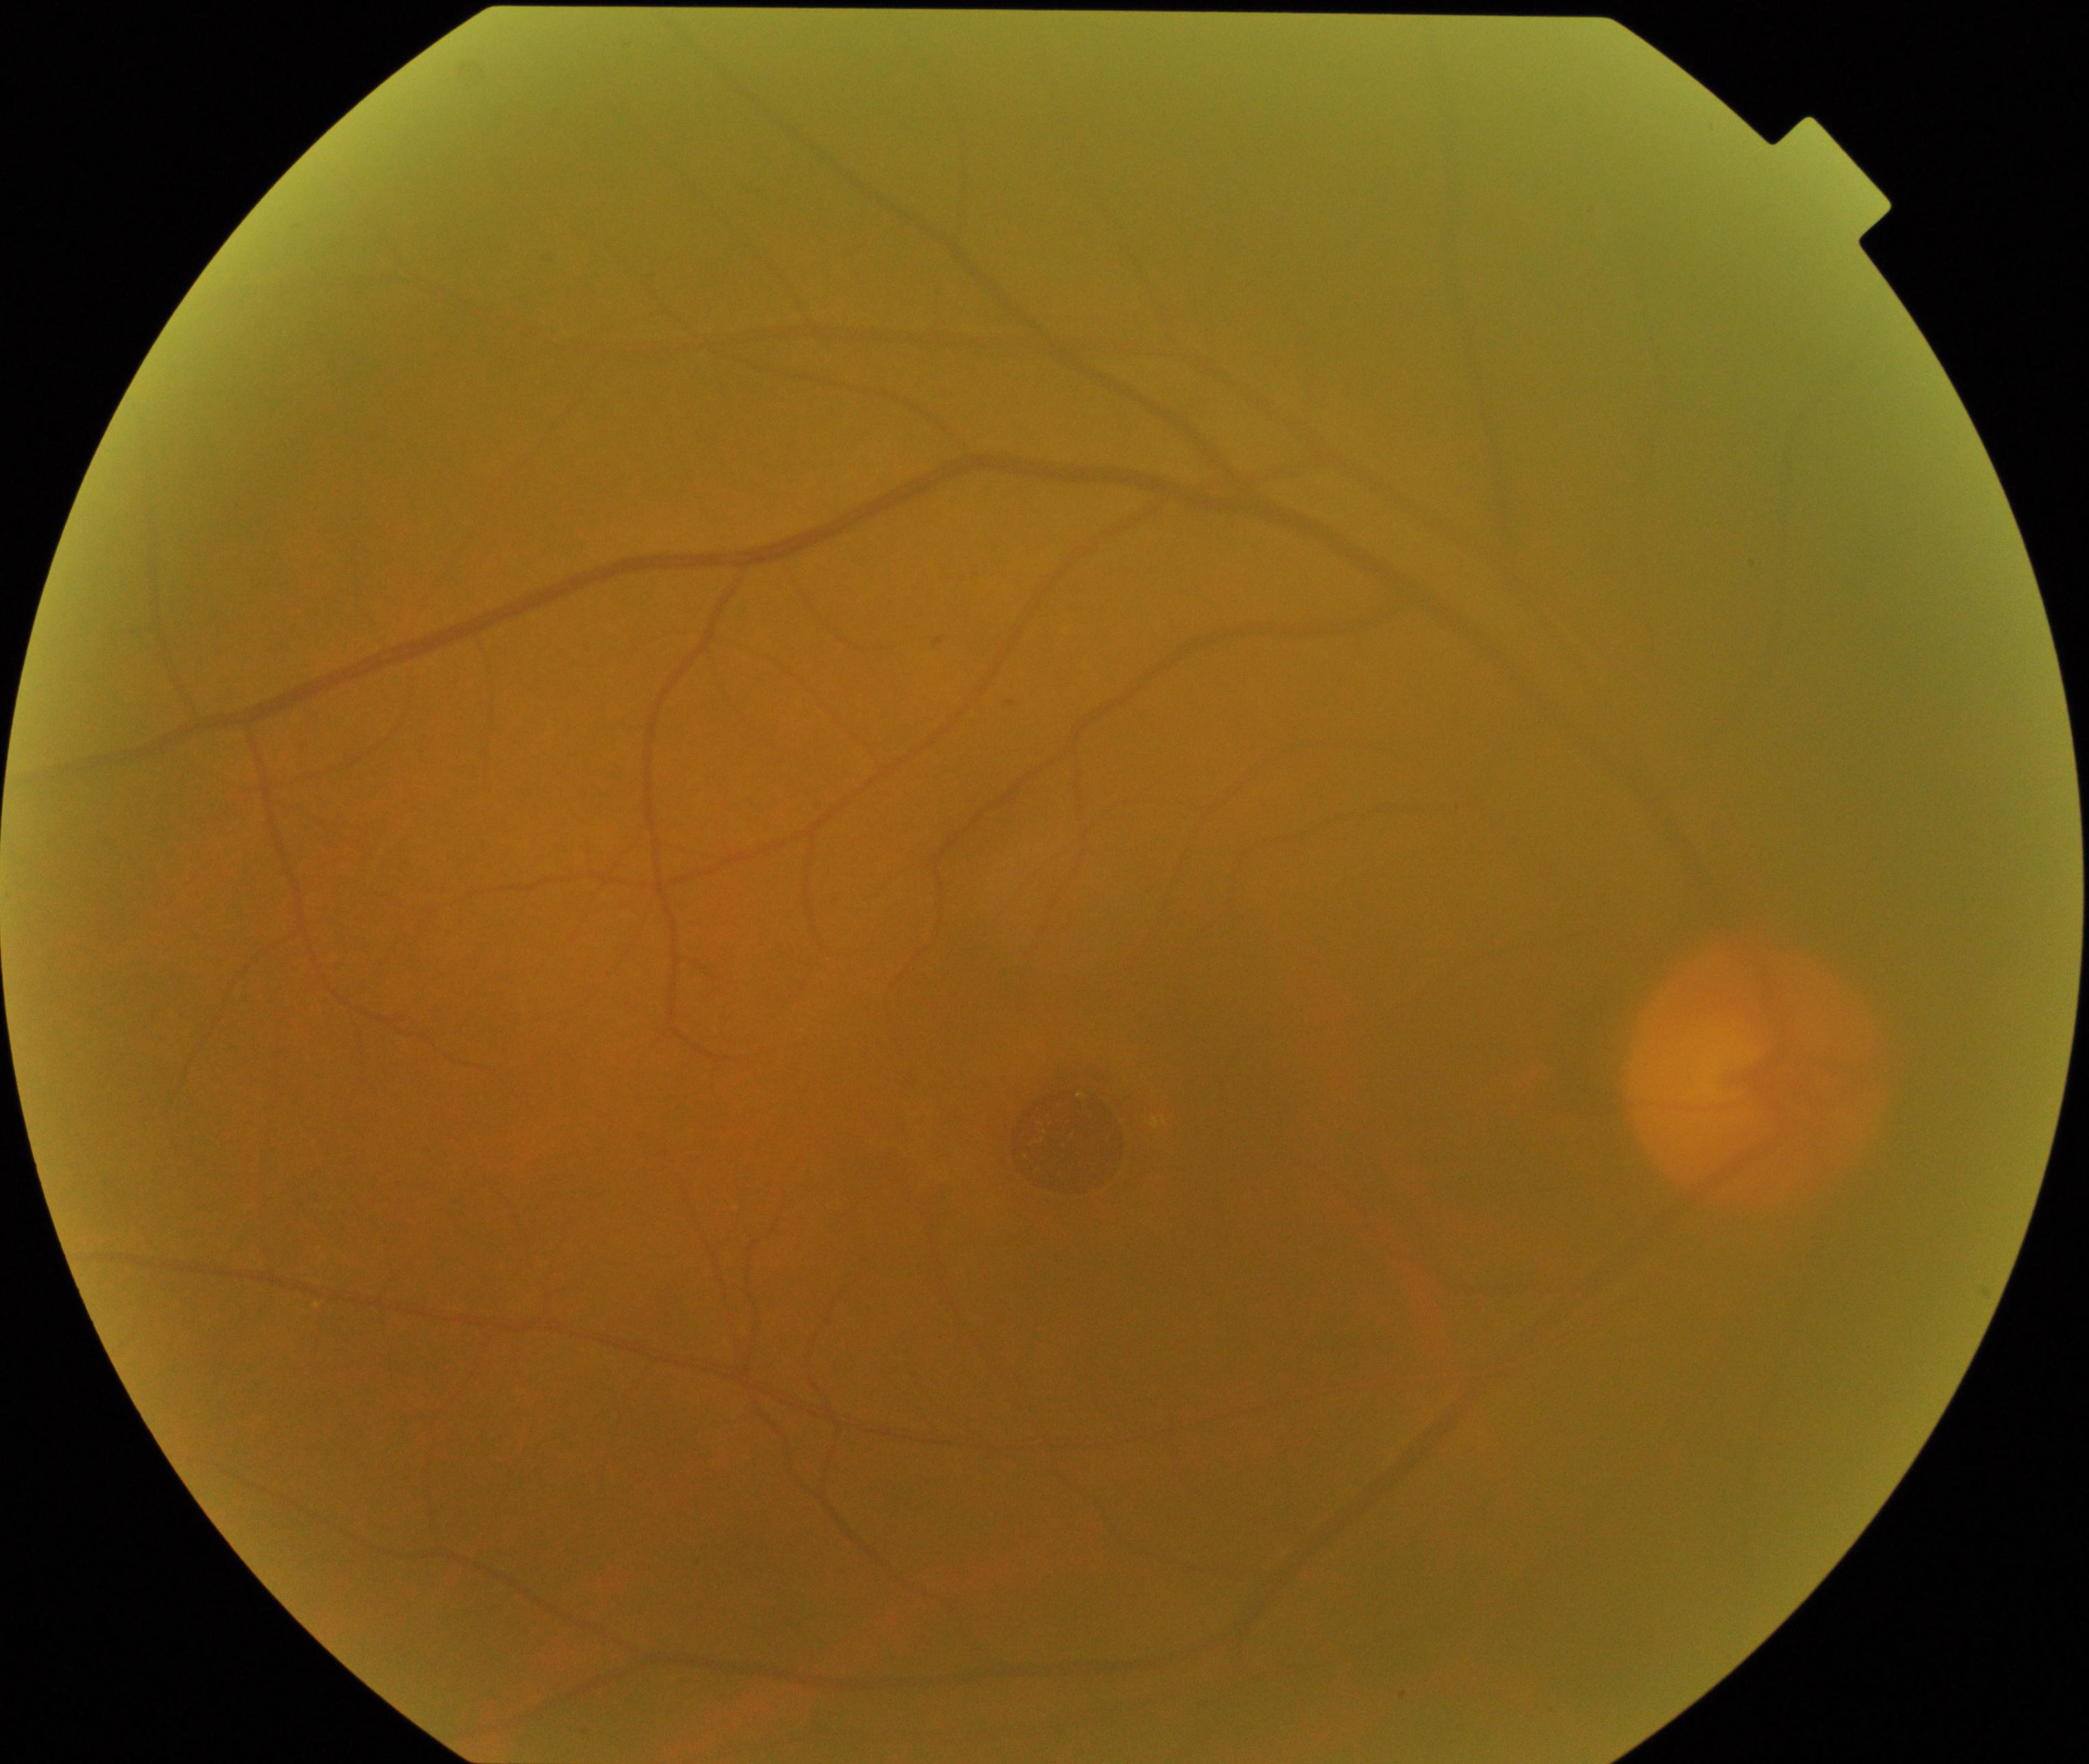

Findings: MH (macular hole).